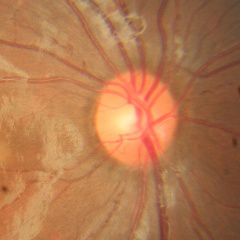 Diagnosis = no signs of glaucoma.